Fundus photo; FOV: 45 degrees; 2352x1568px:
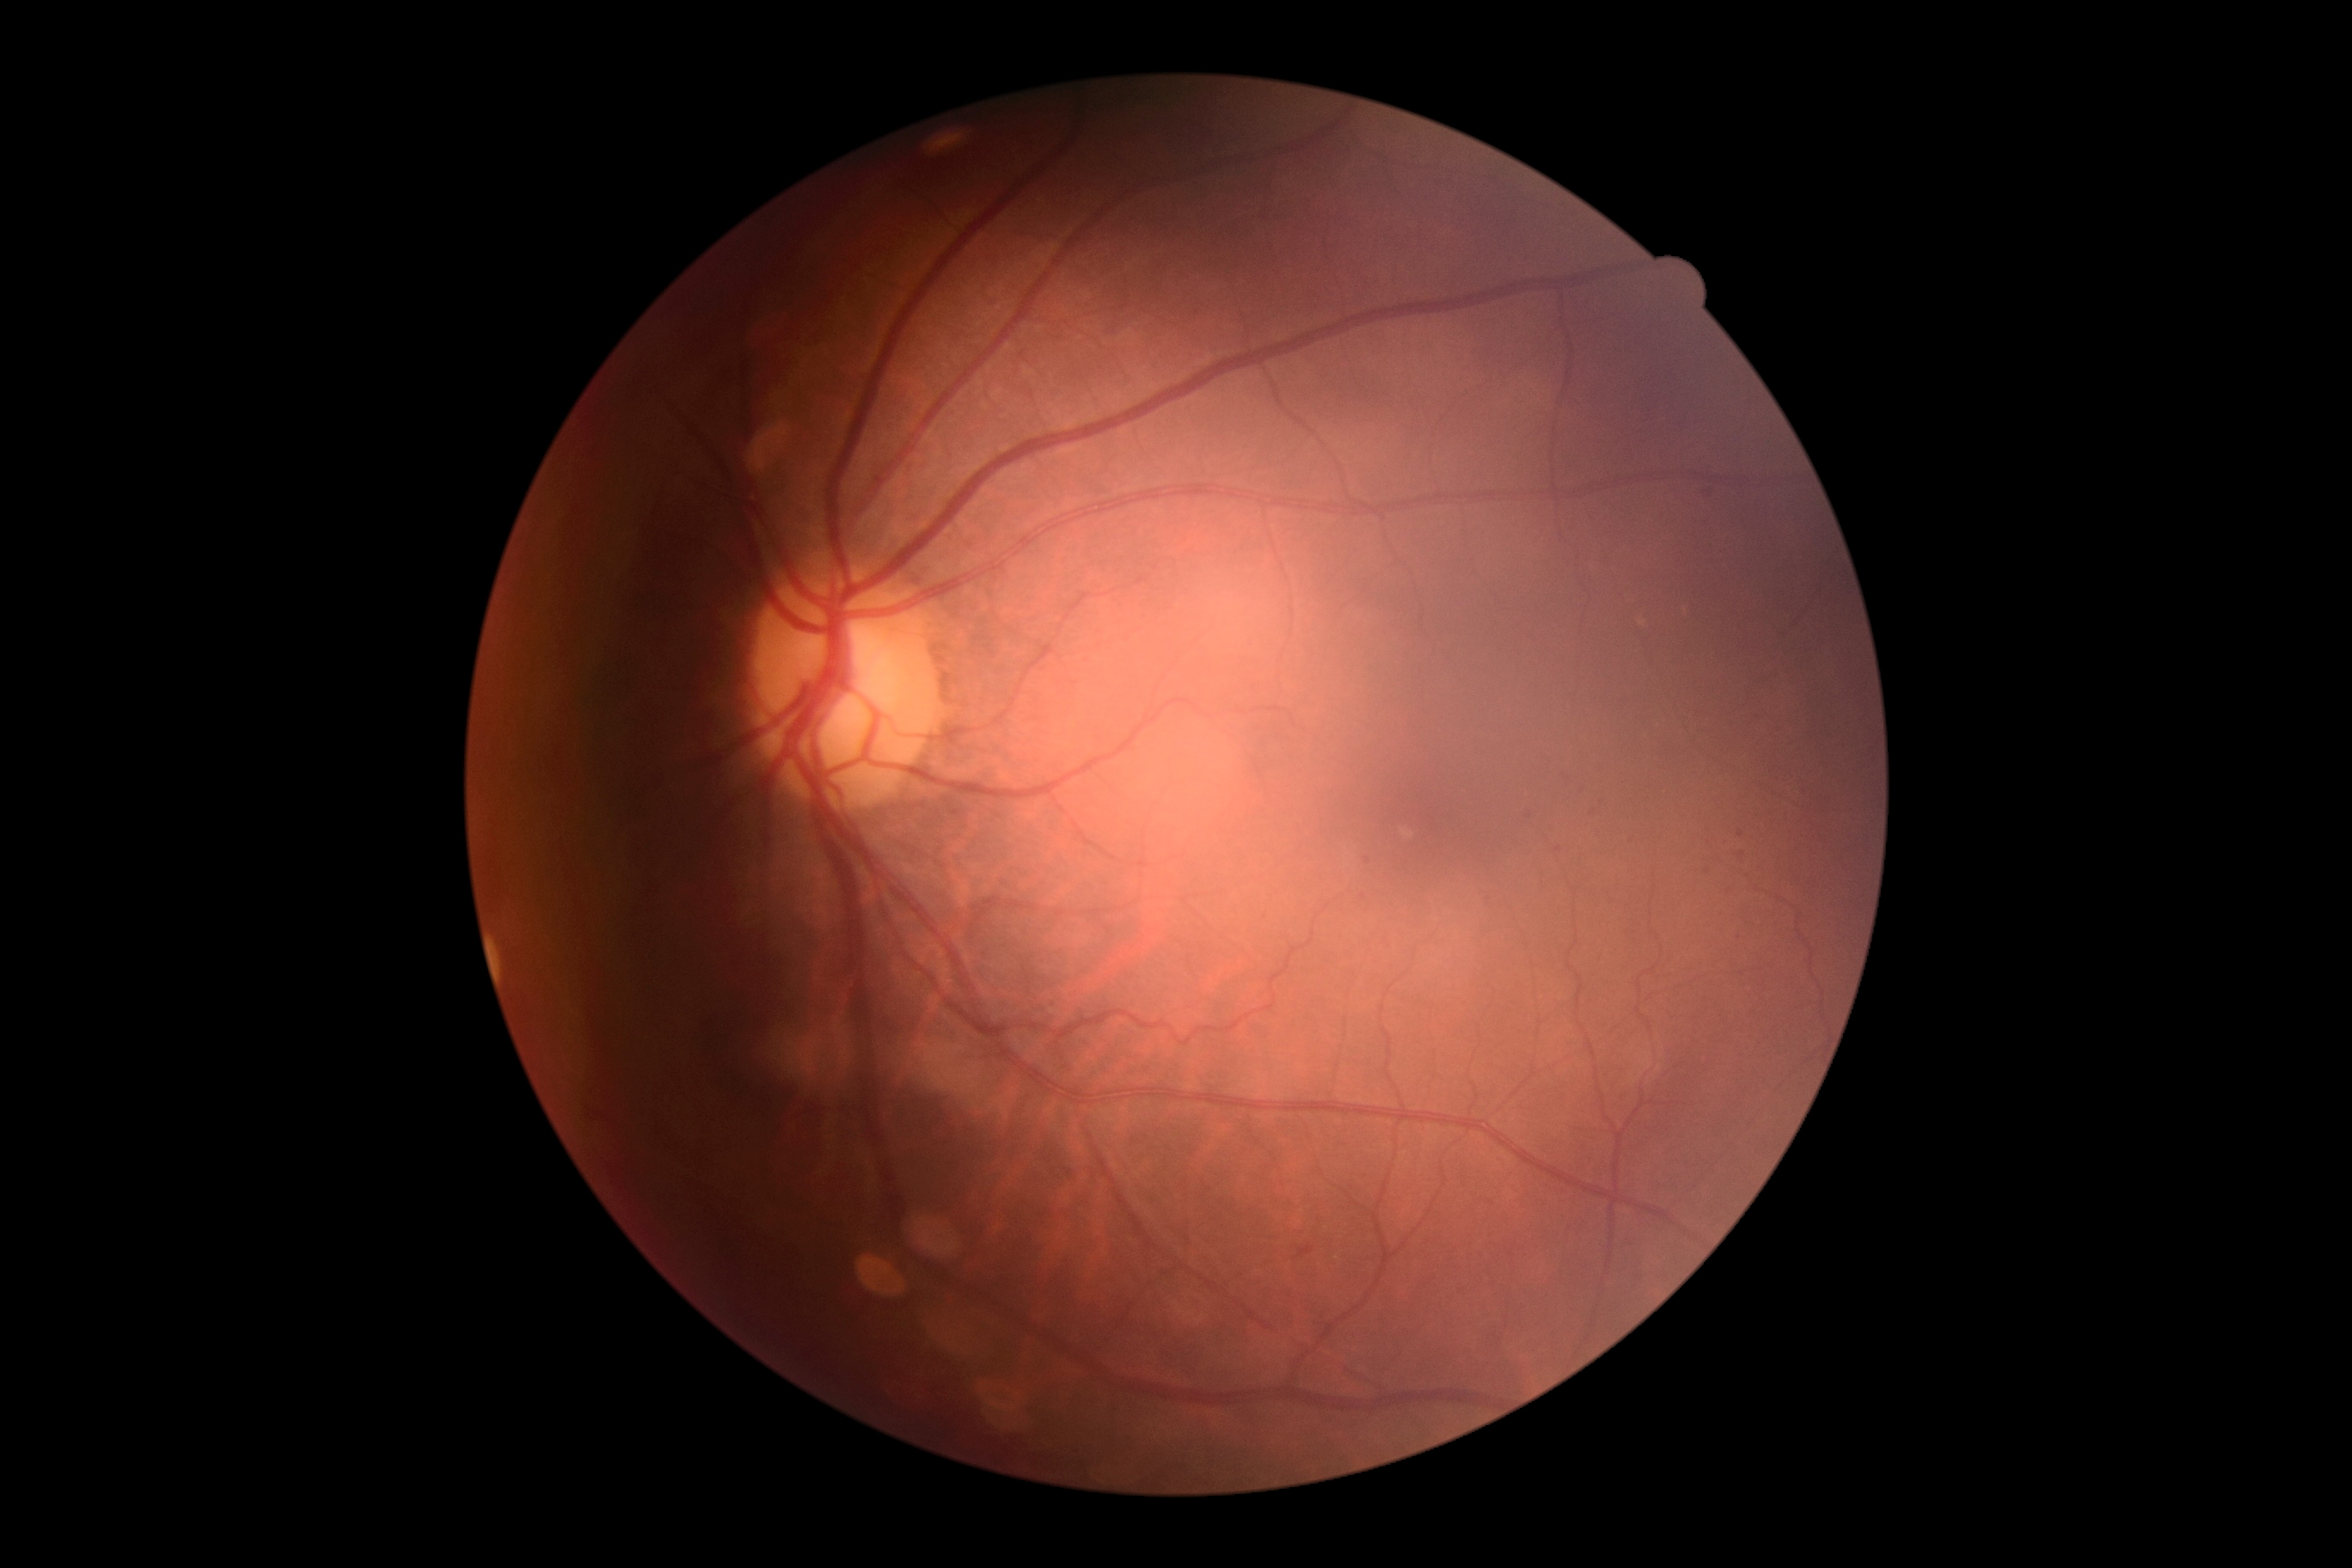
DR stage is grade 2.